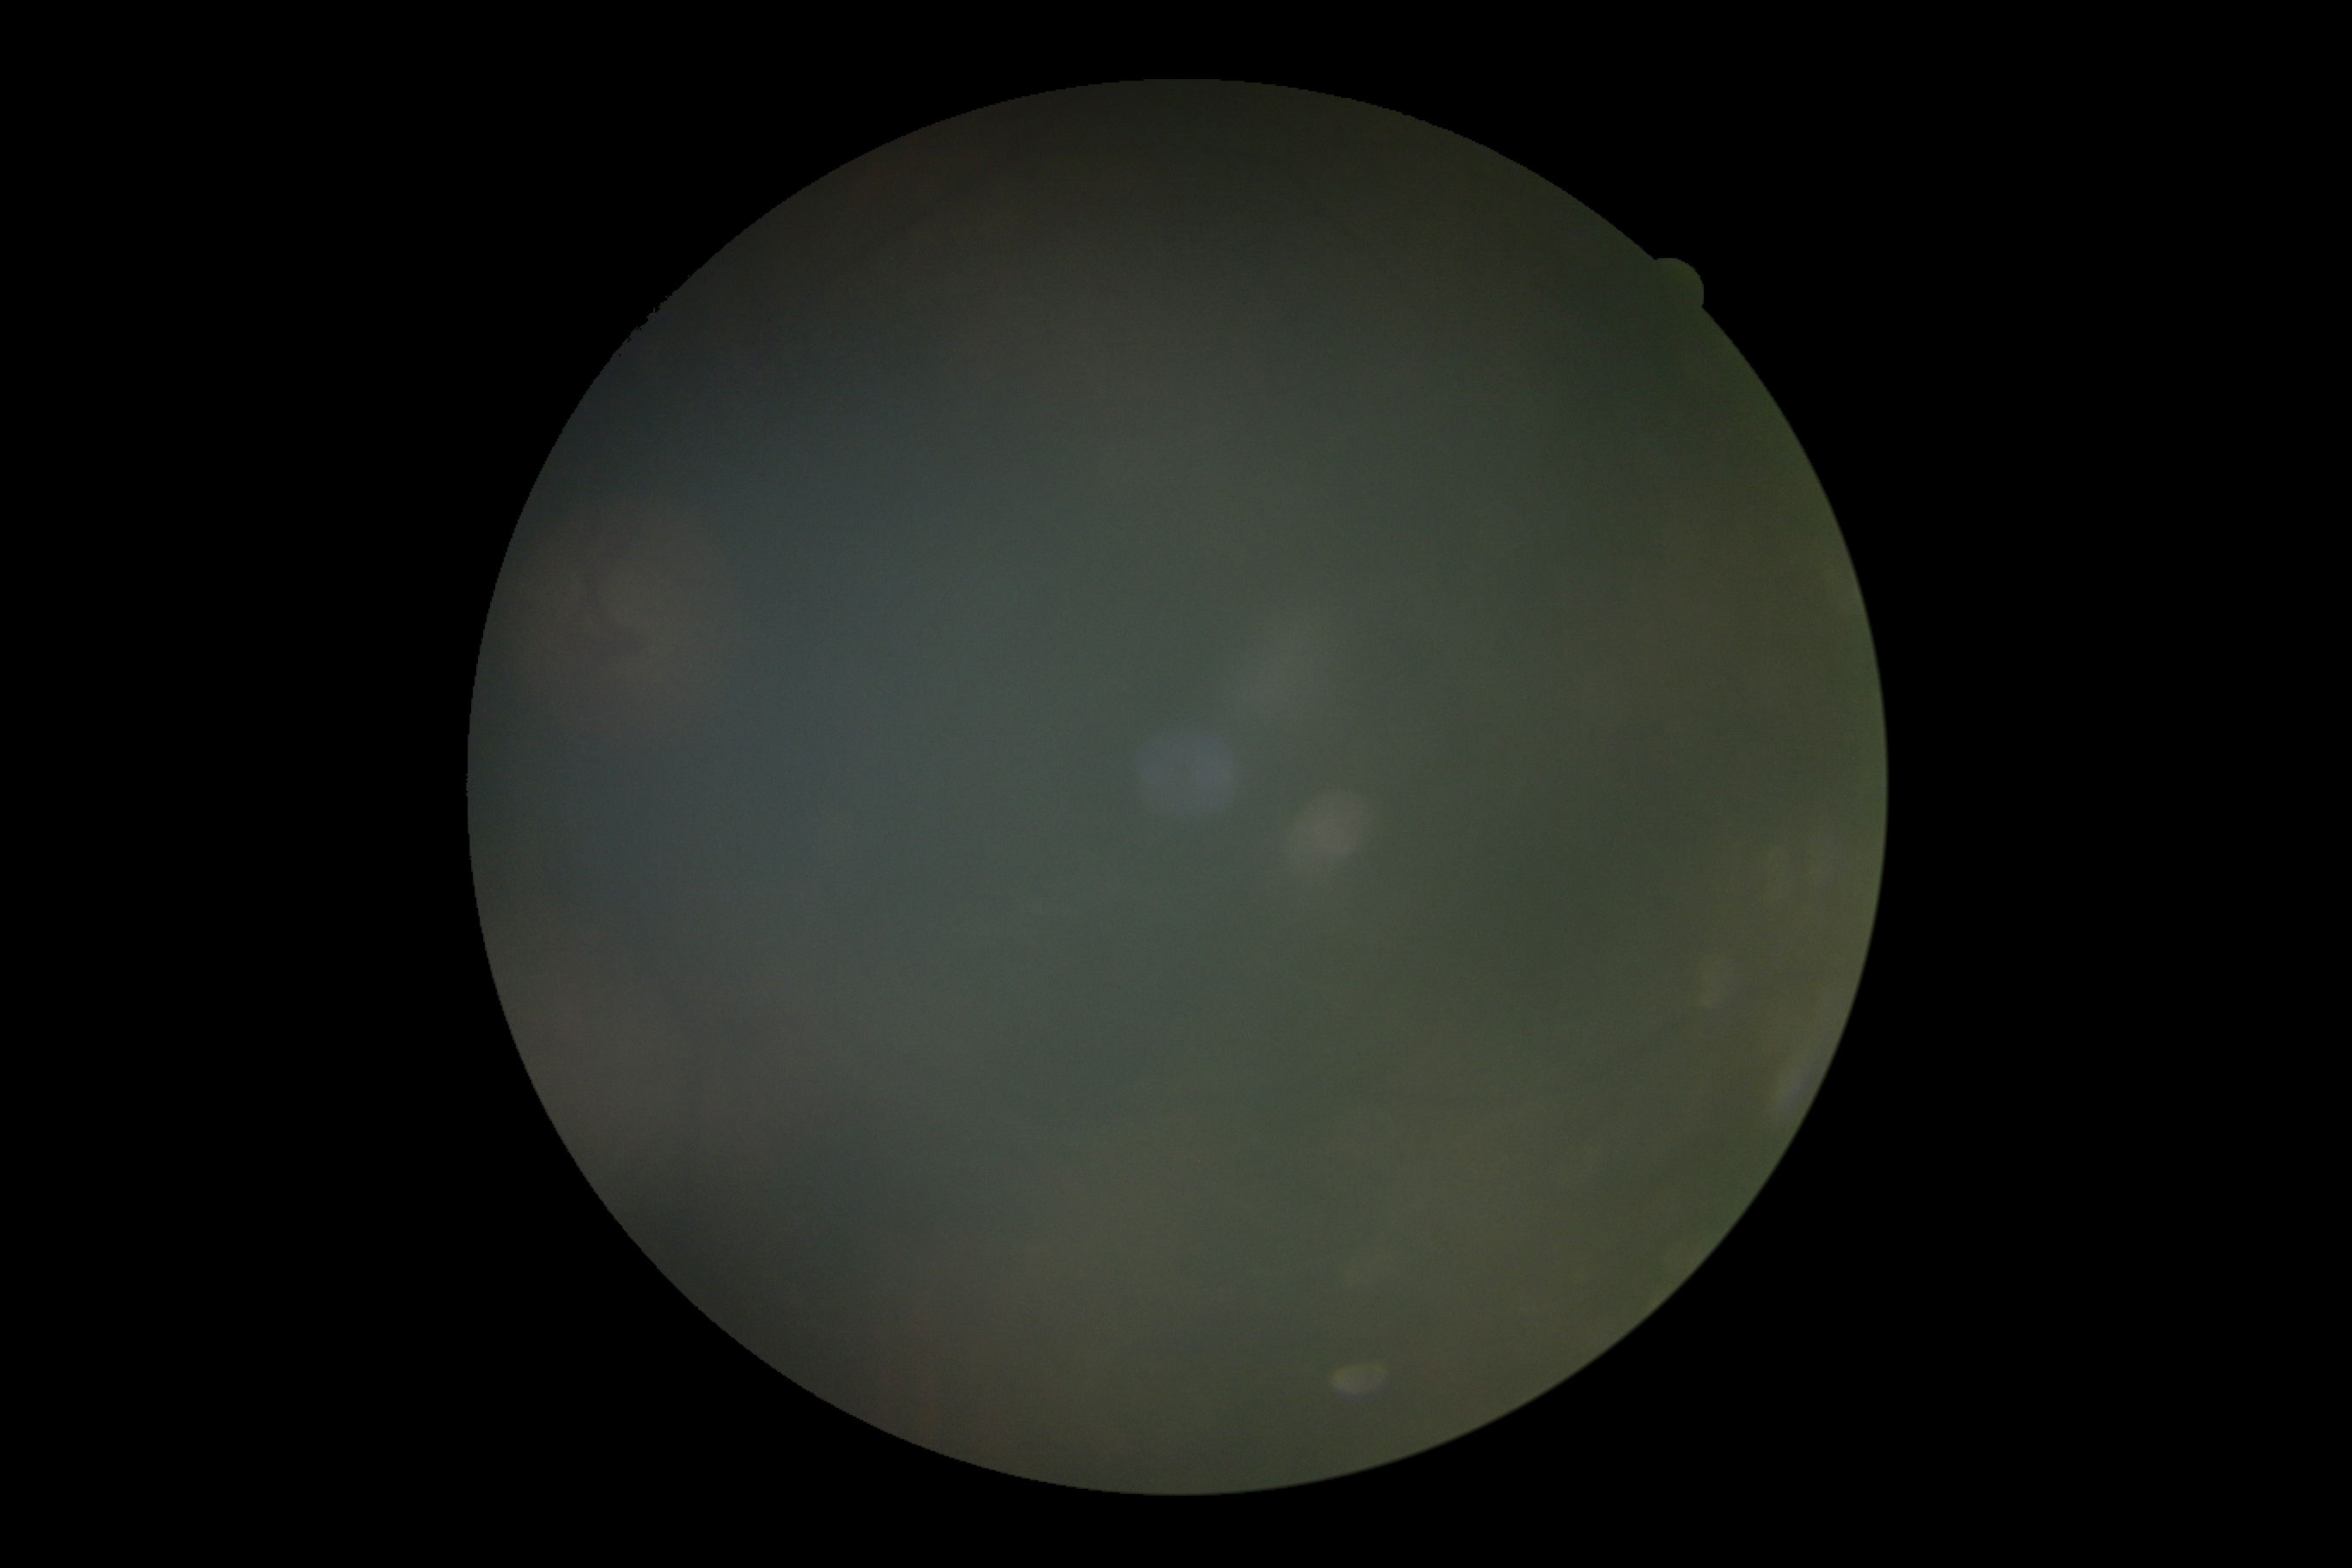

DR: ungradable. Ungradable image — DR severity cannot be determined.